45° FOV; CFP:
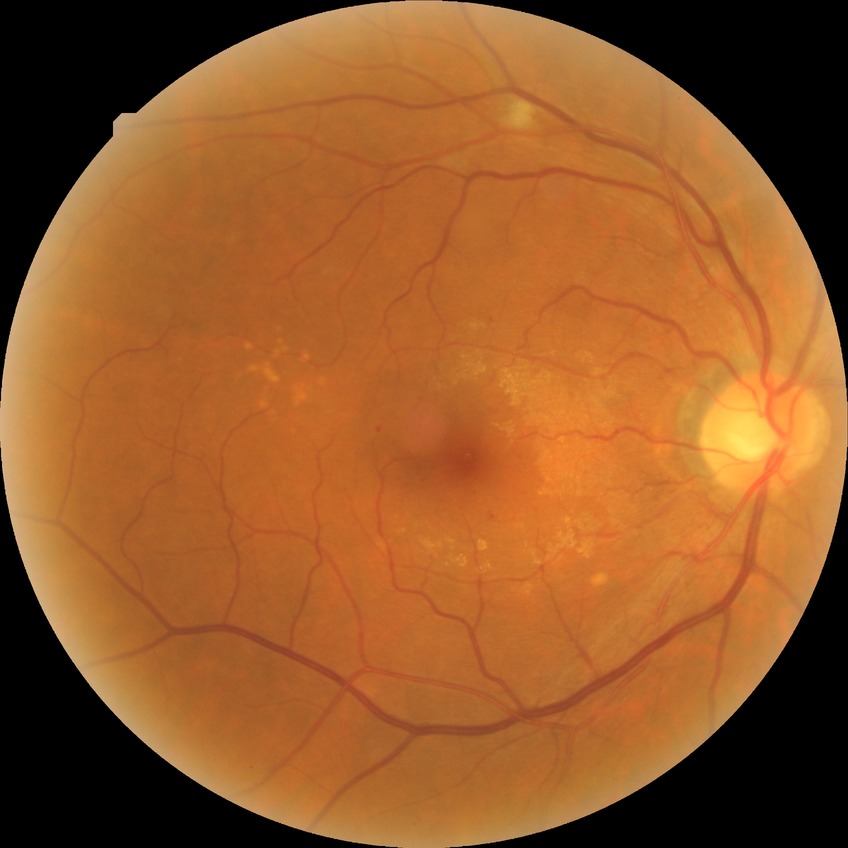 Diabetic retinopathy stage is simple diabetic retinopathy.